Captured after pupil dilation
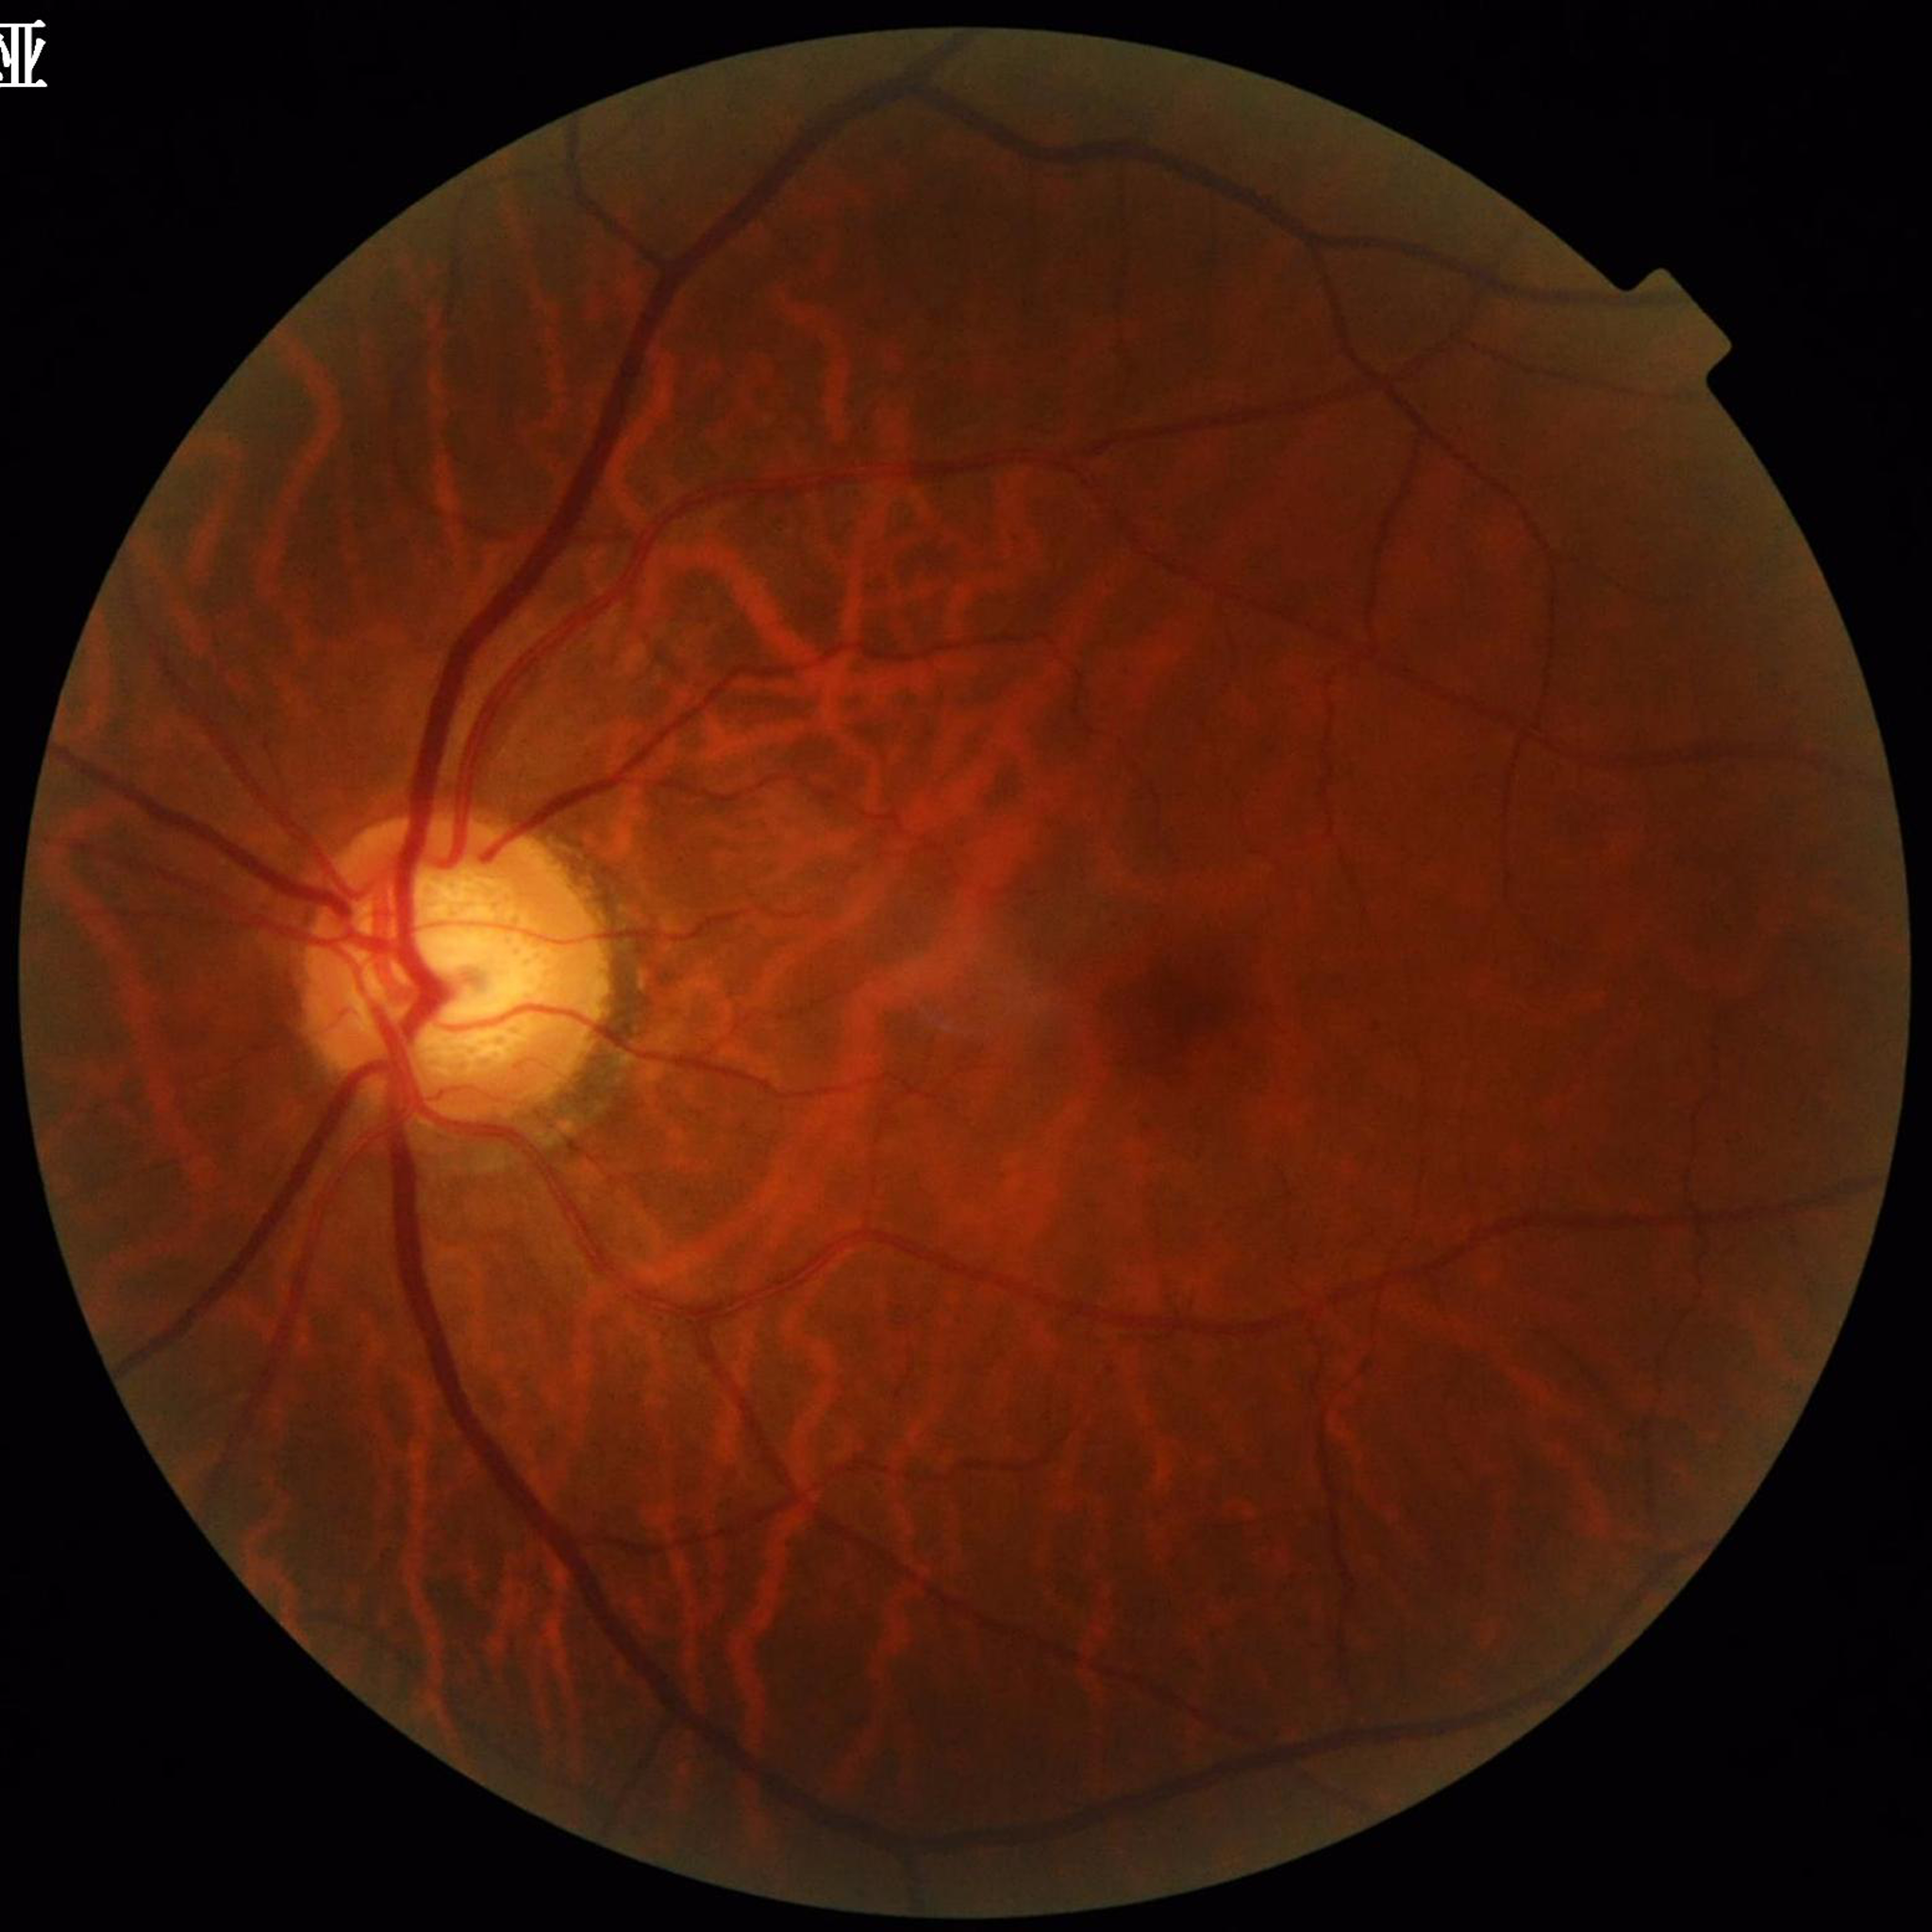 Patient diagnosed with glaucoma.